Wide-field fundus photograph of an infant: 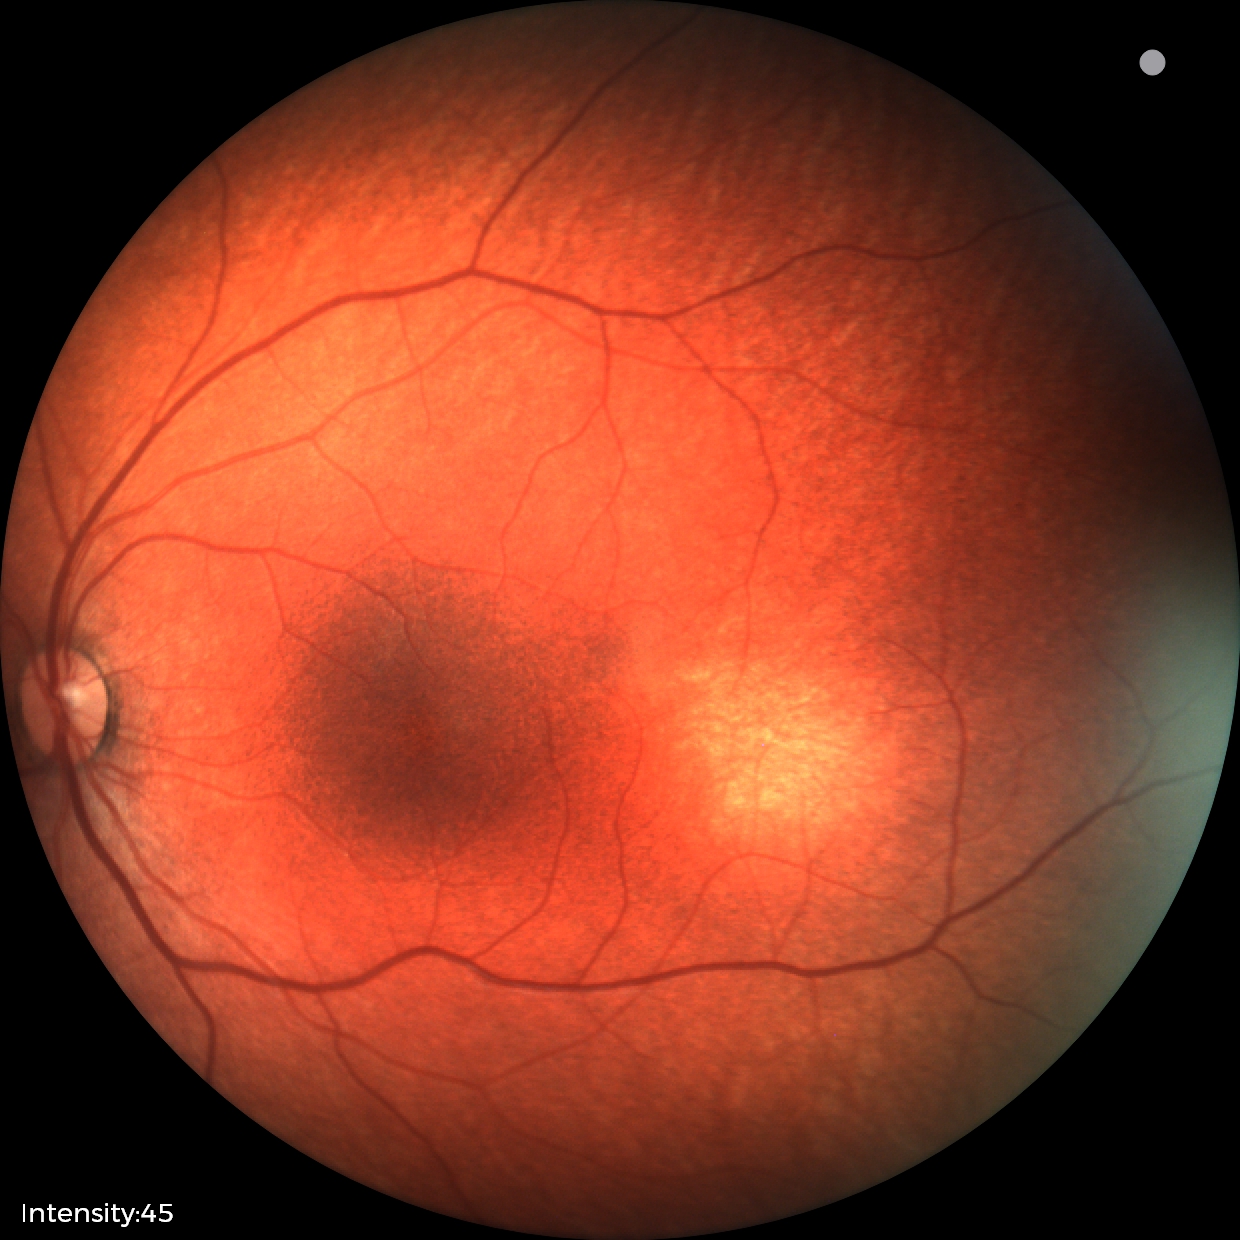
Screening examination diagnosed as physiological.